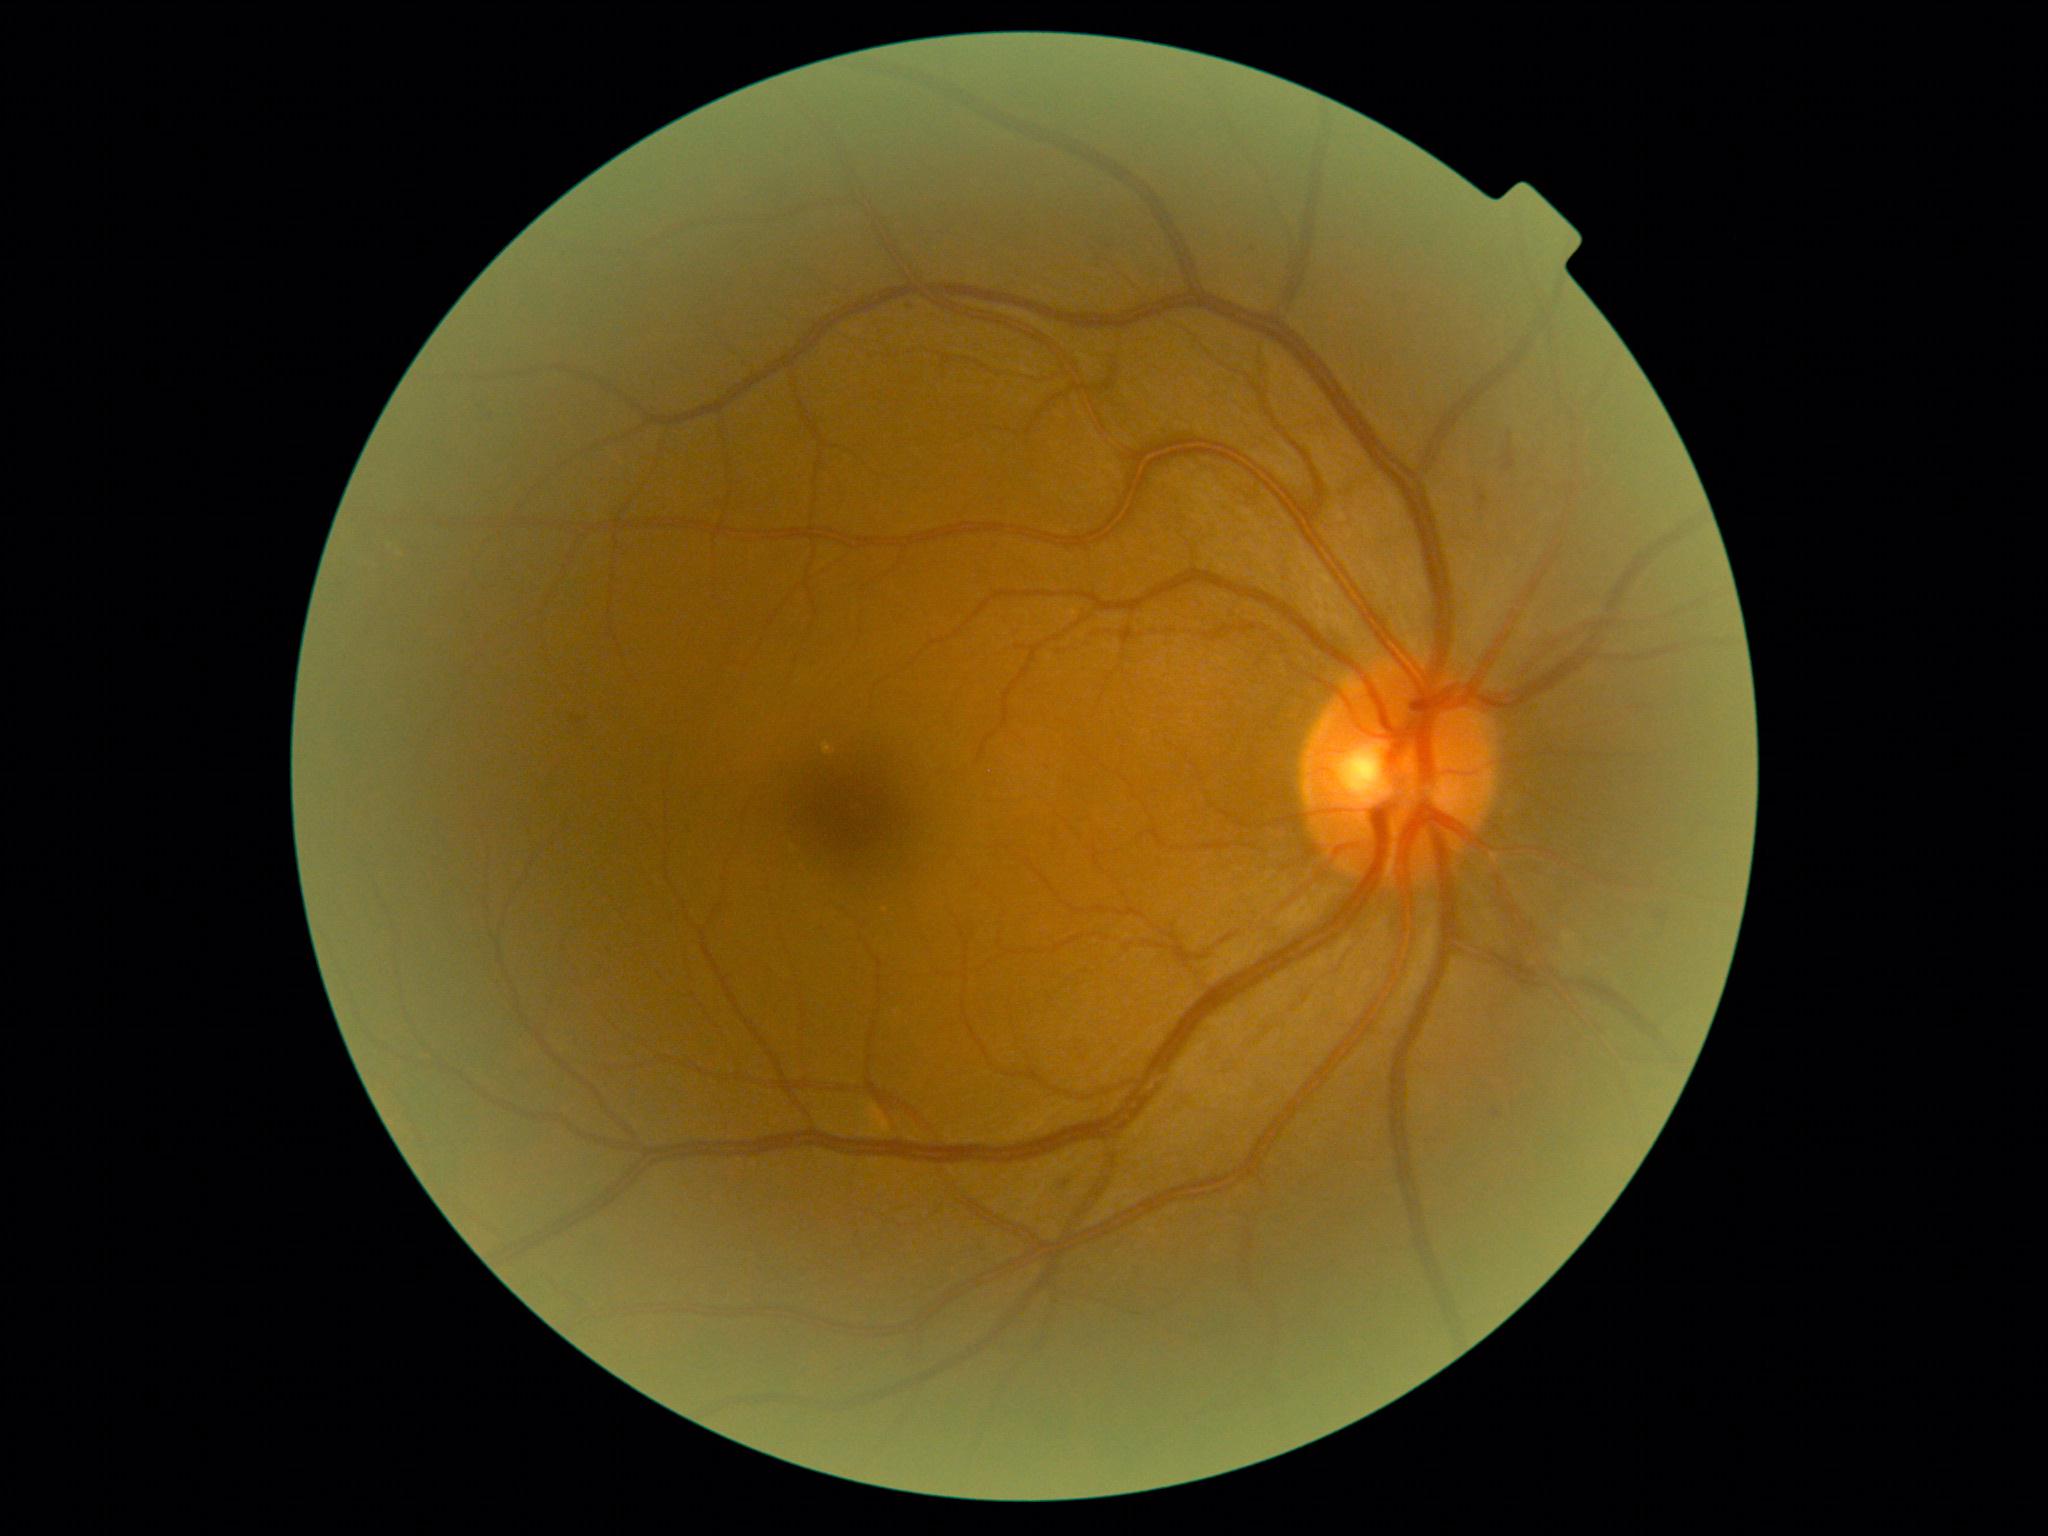

DR = grade 2 (moderate NPDR).